NIDEK AFC-230 fundus camera, image size 848x848:
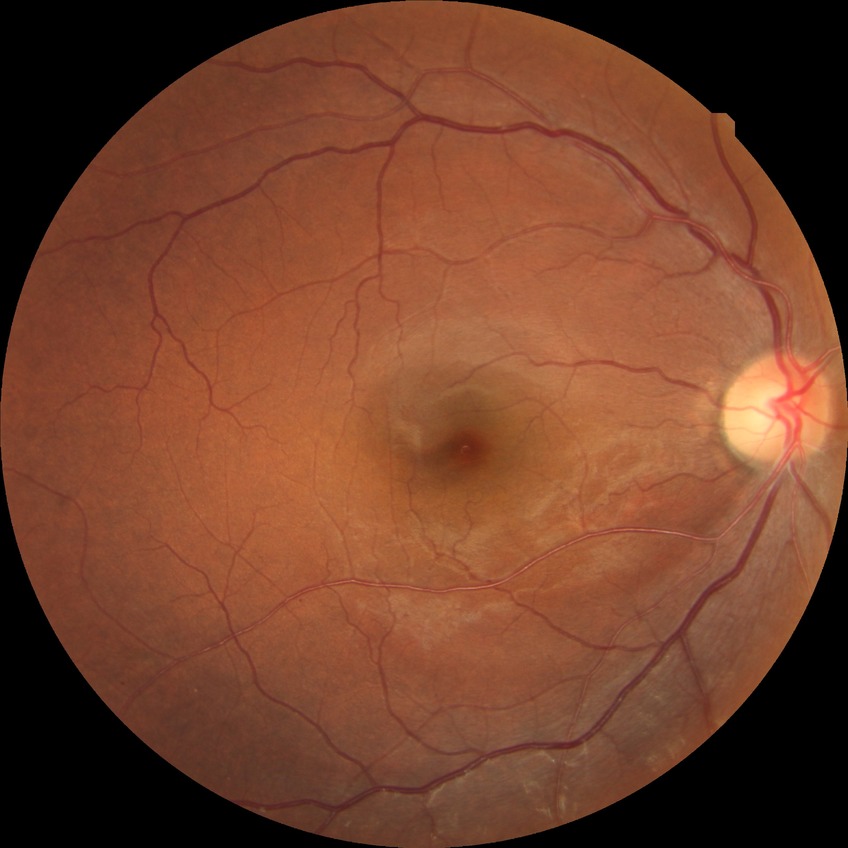
Diabetic retinopathy (DR) is no diabetic retinopathy (NDR).